2352 x 1568 pixels. 45° field of view. Color fundus image
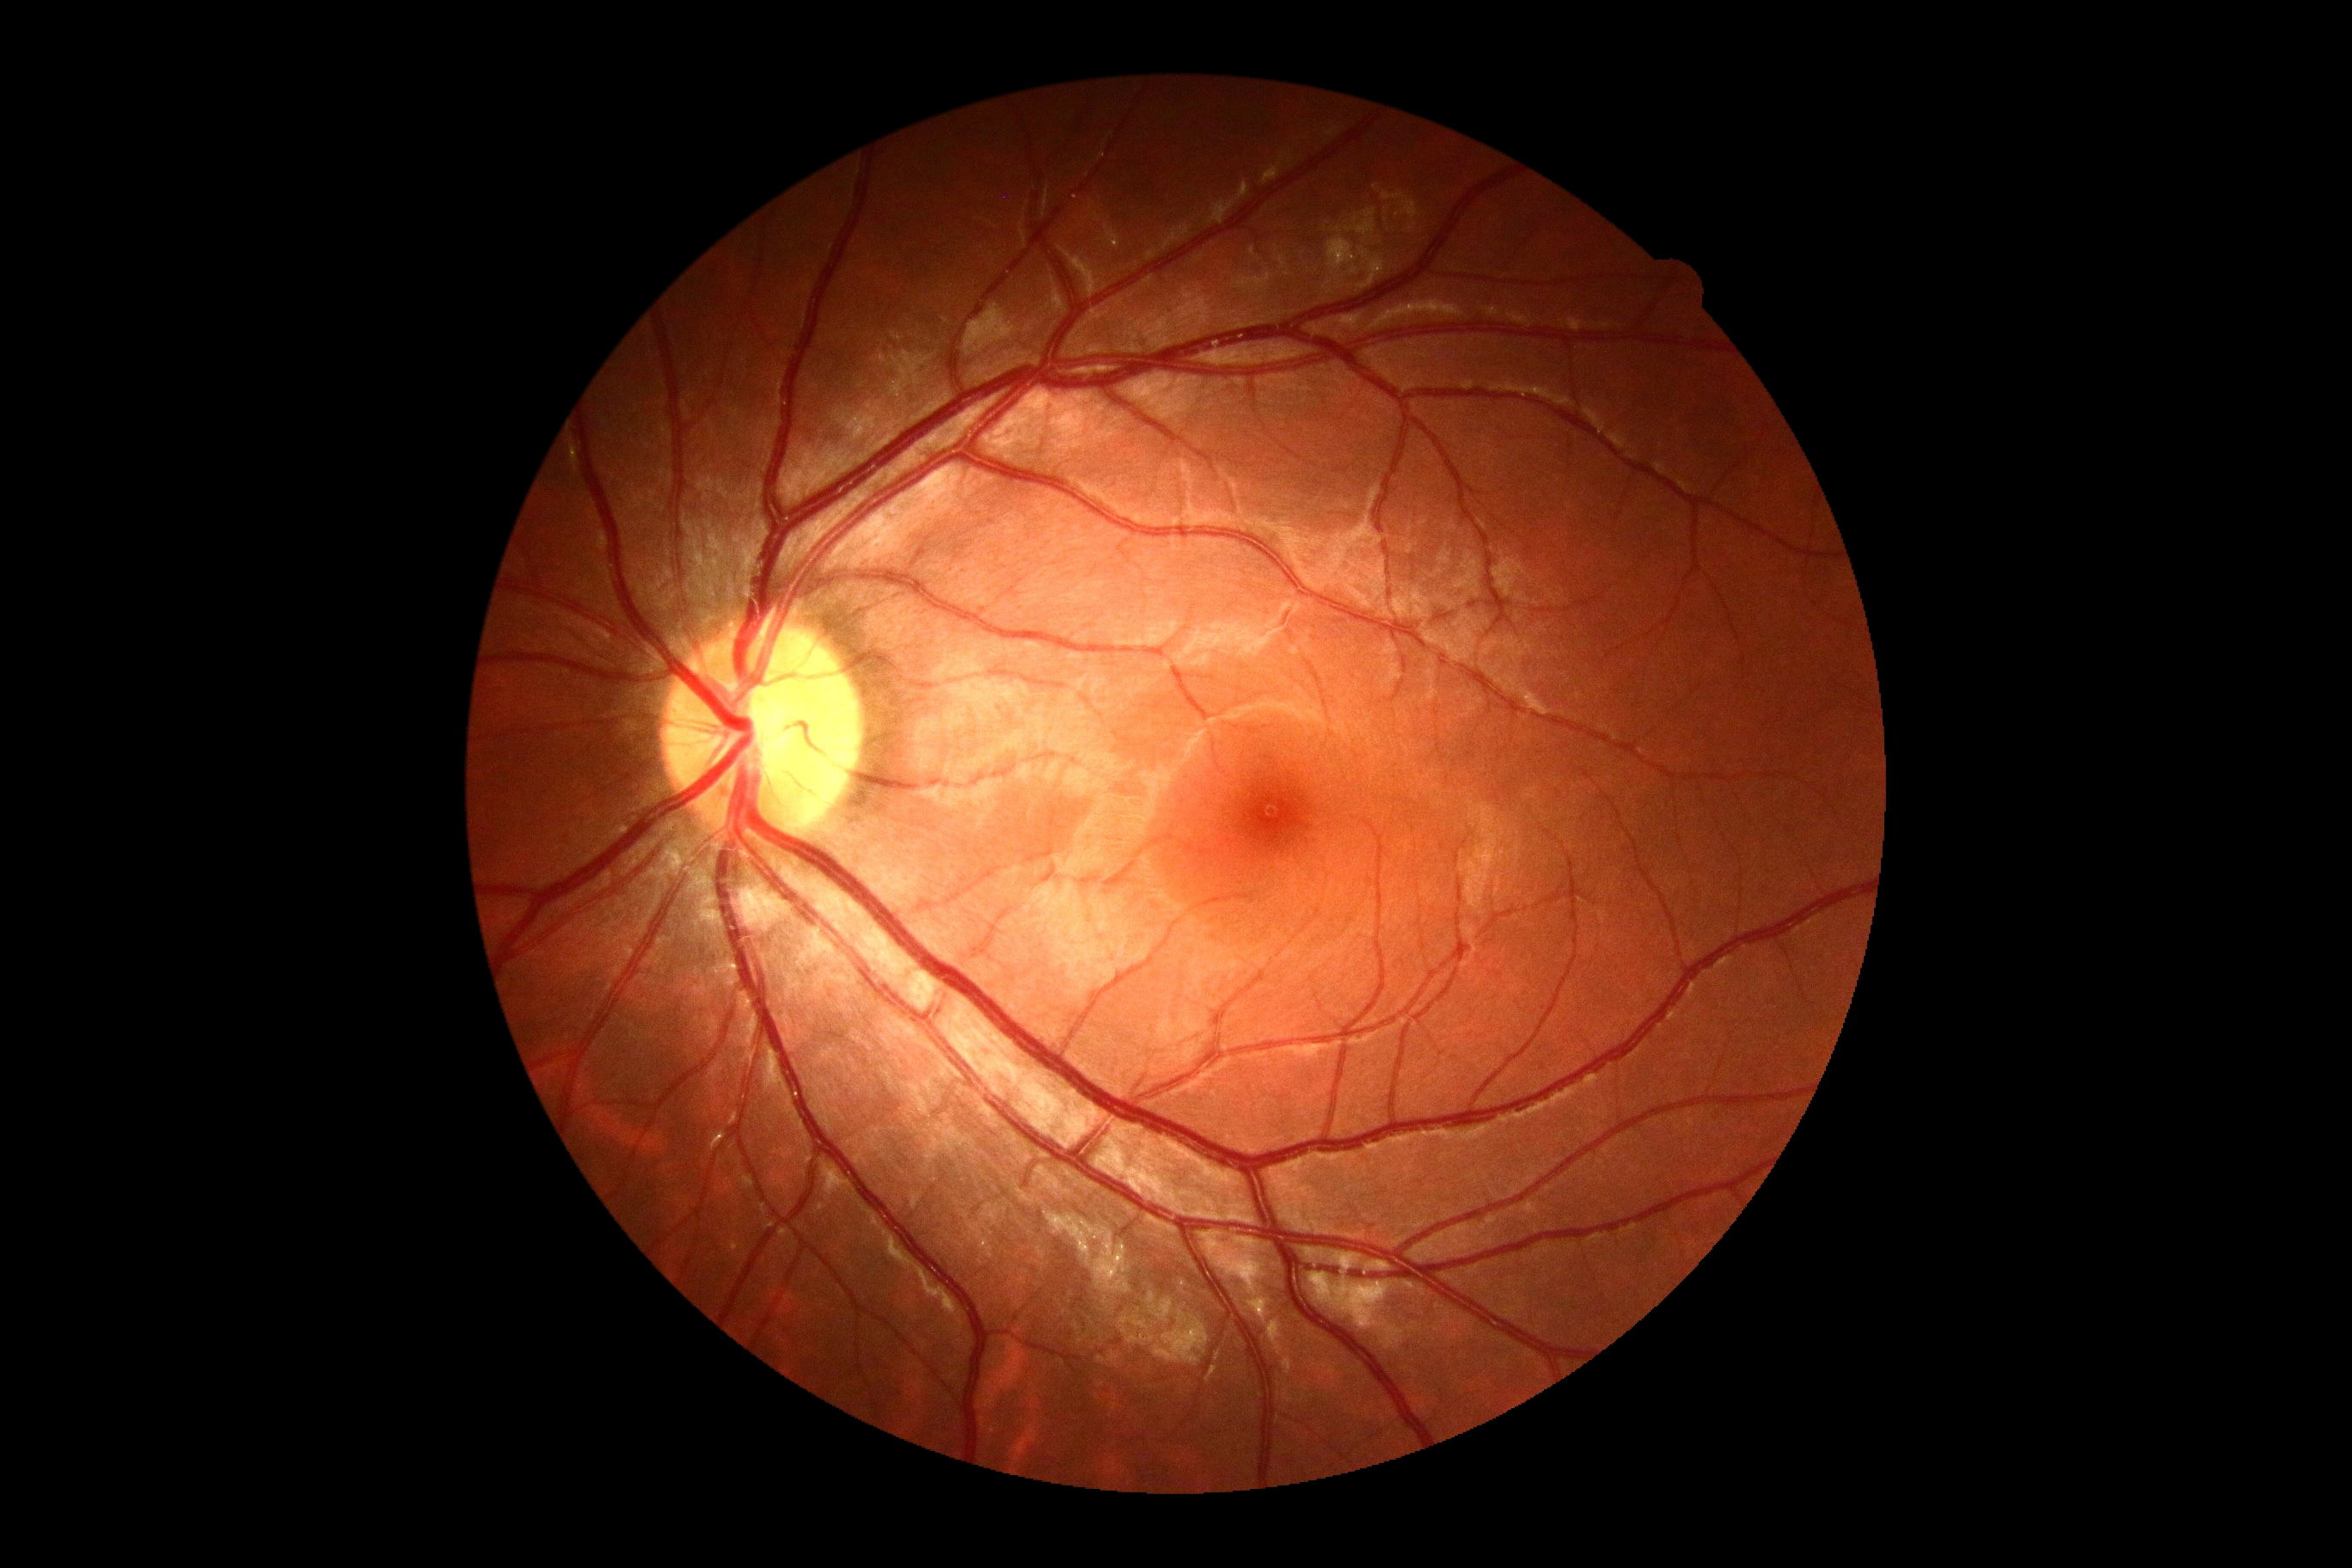
No apparent diabetic retinopathy. Retinopathy grade is no apparent diabetic retinopathy (0).